45° field of view.
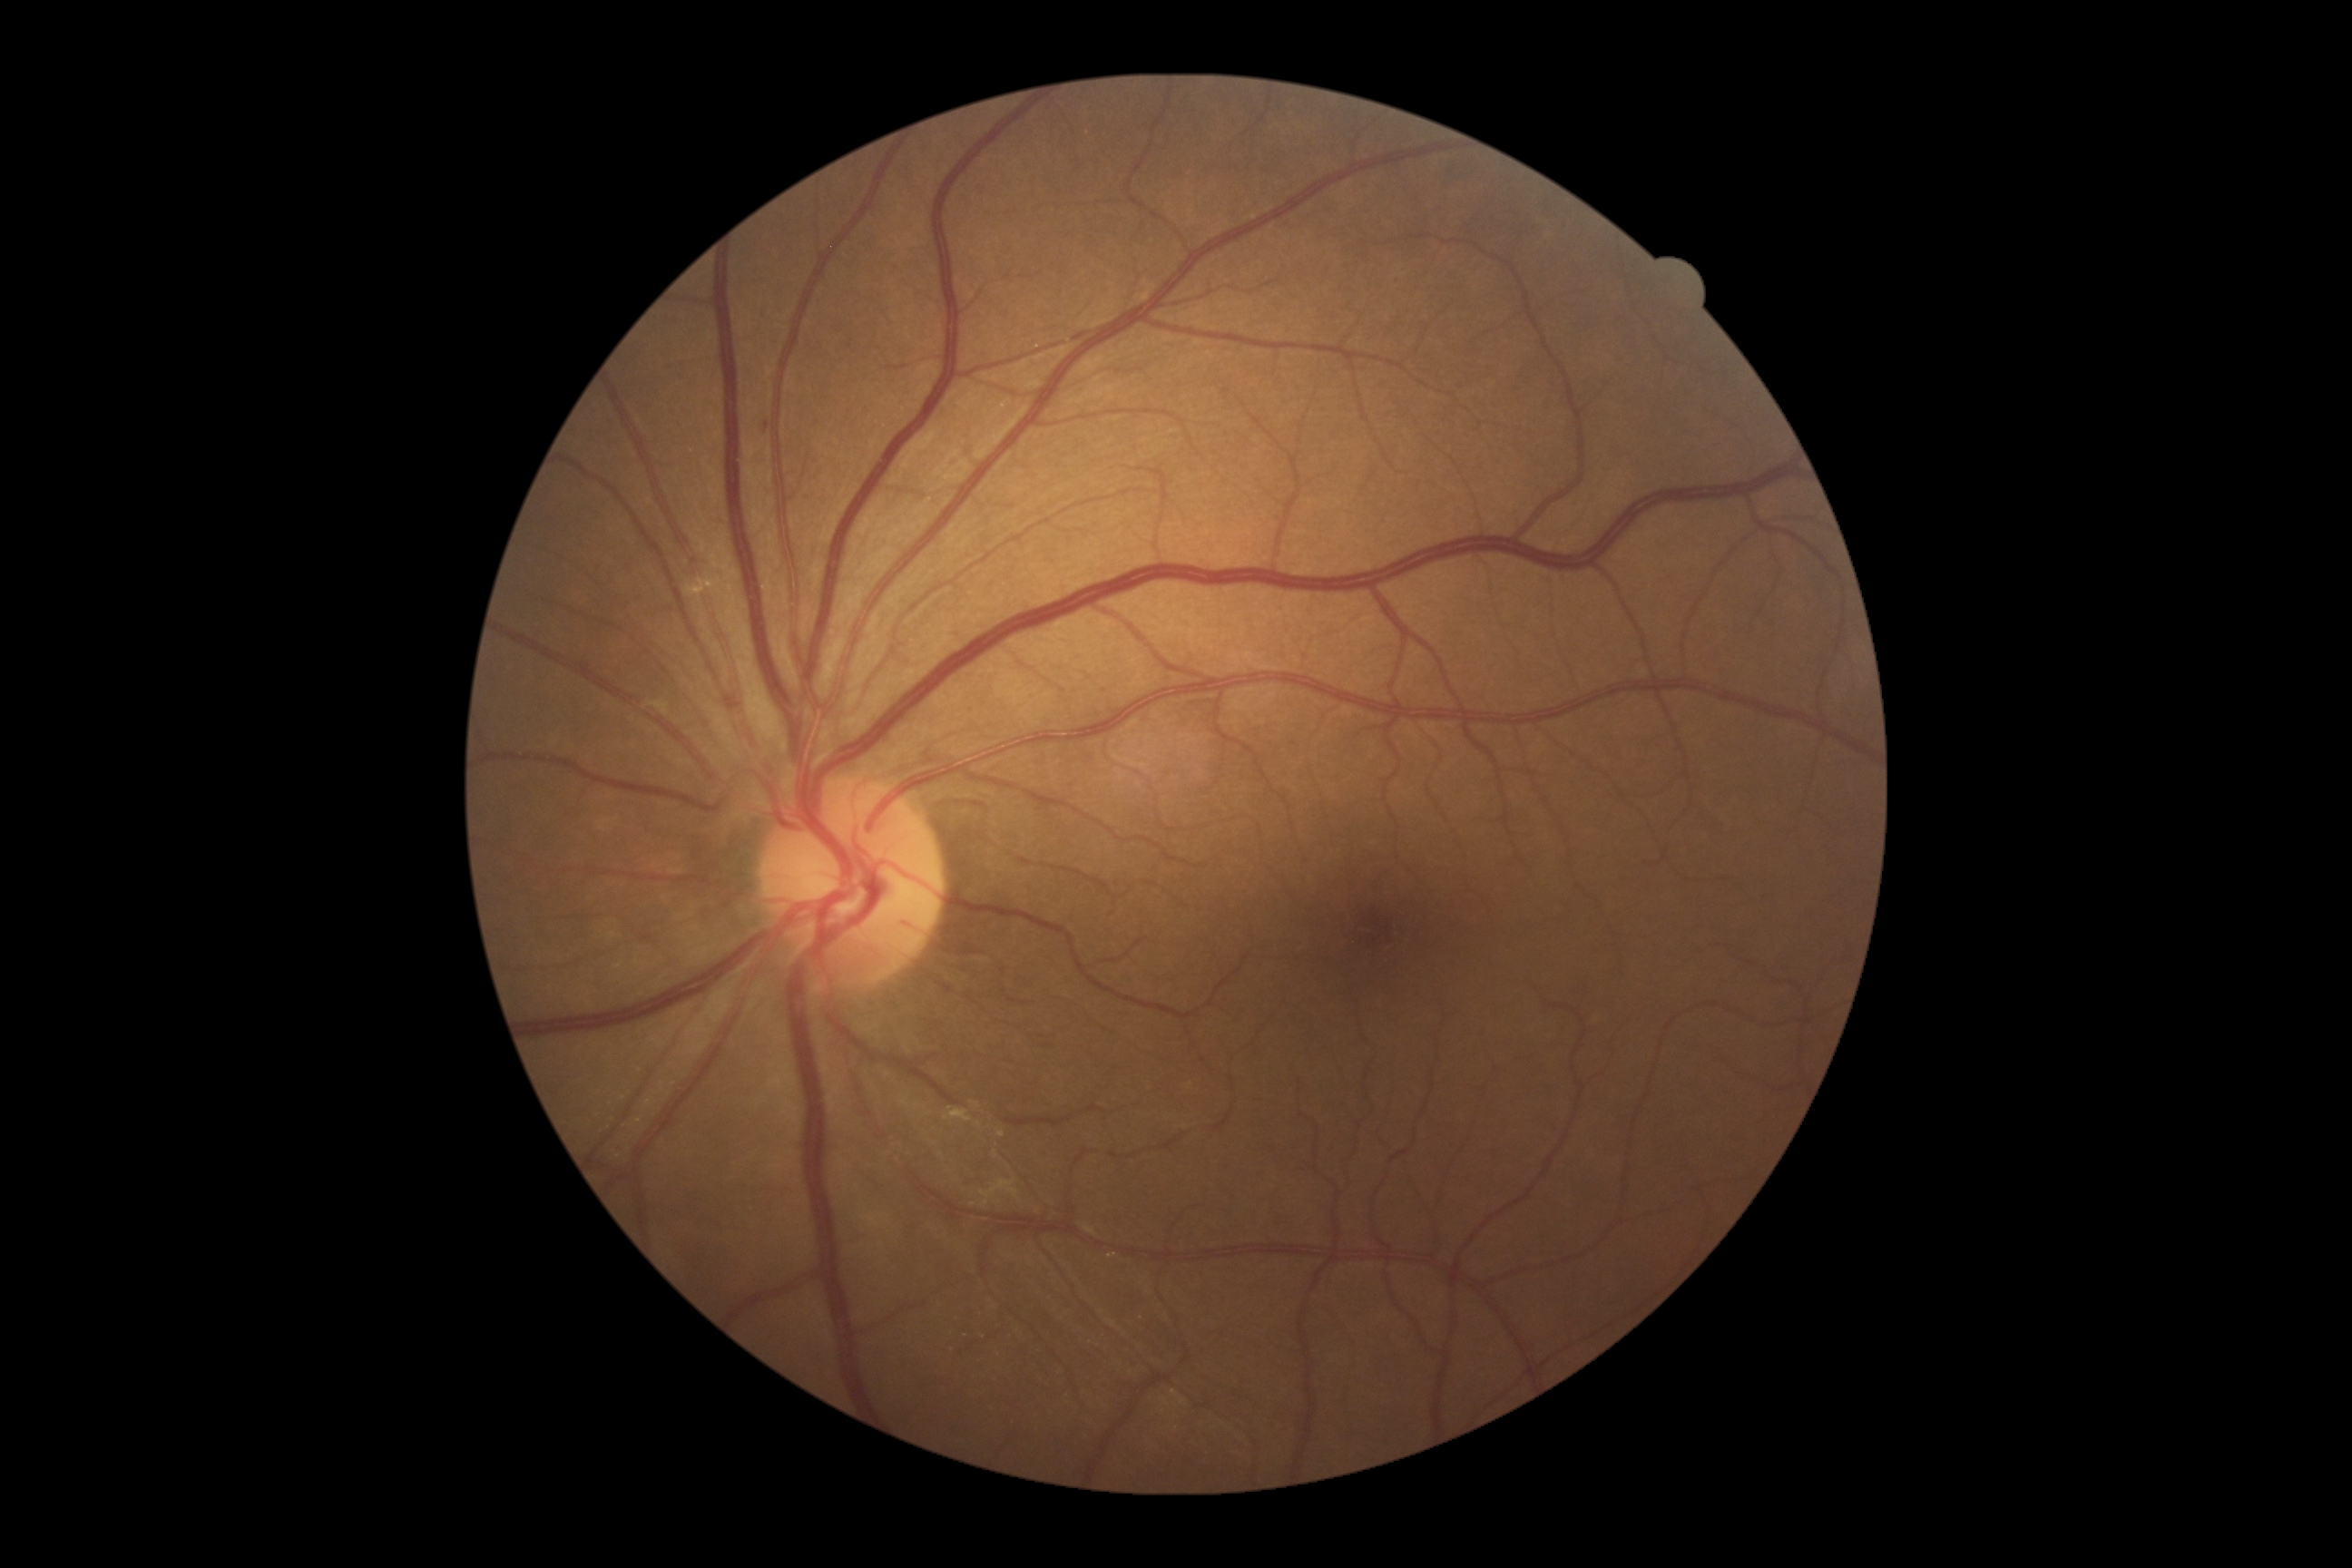 diabetic retinopathy (DR)@grade 1, DR class@non-proliferative diabetic retinopathy.